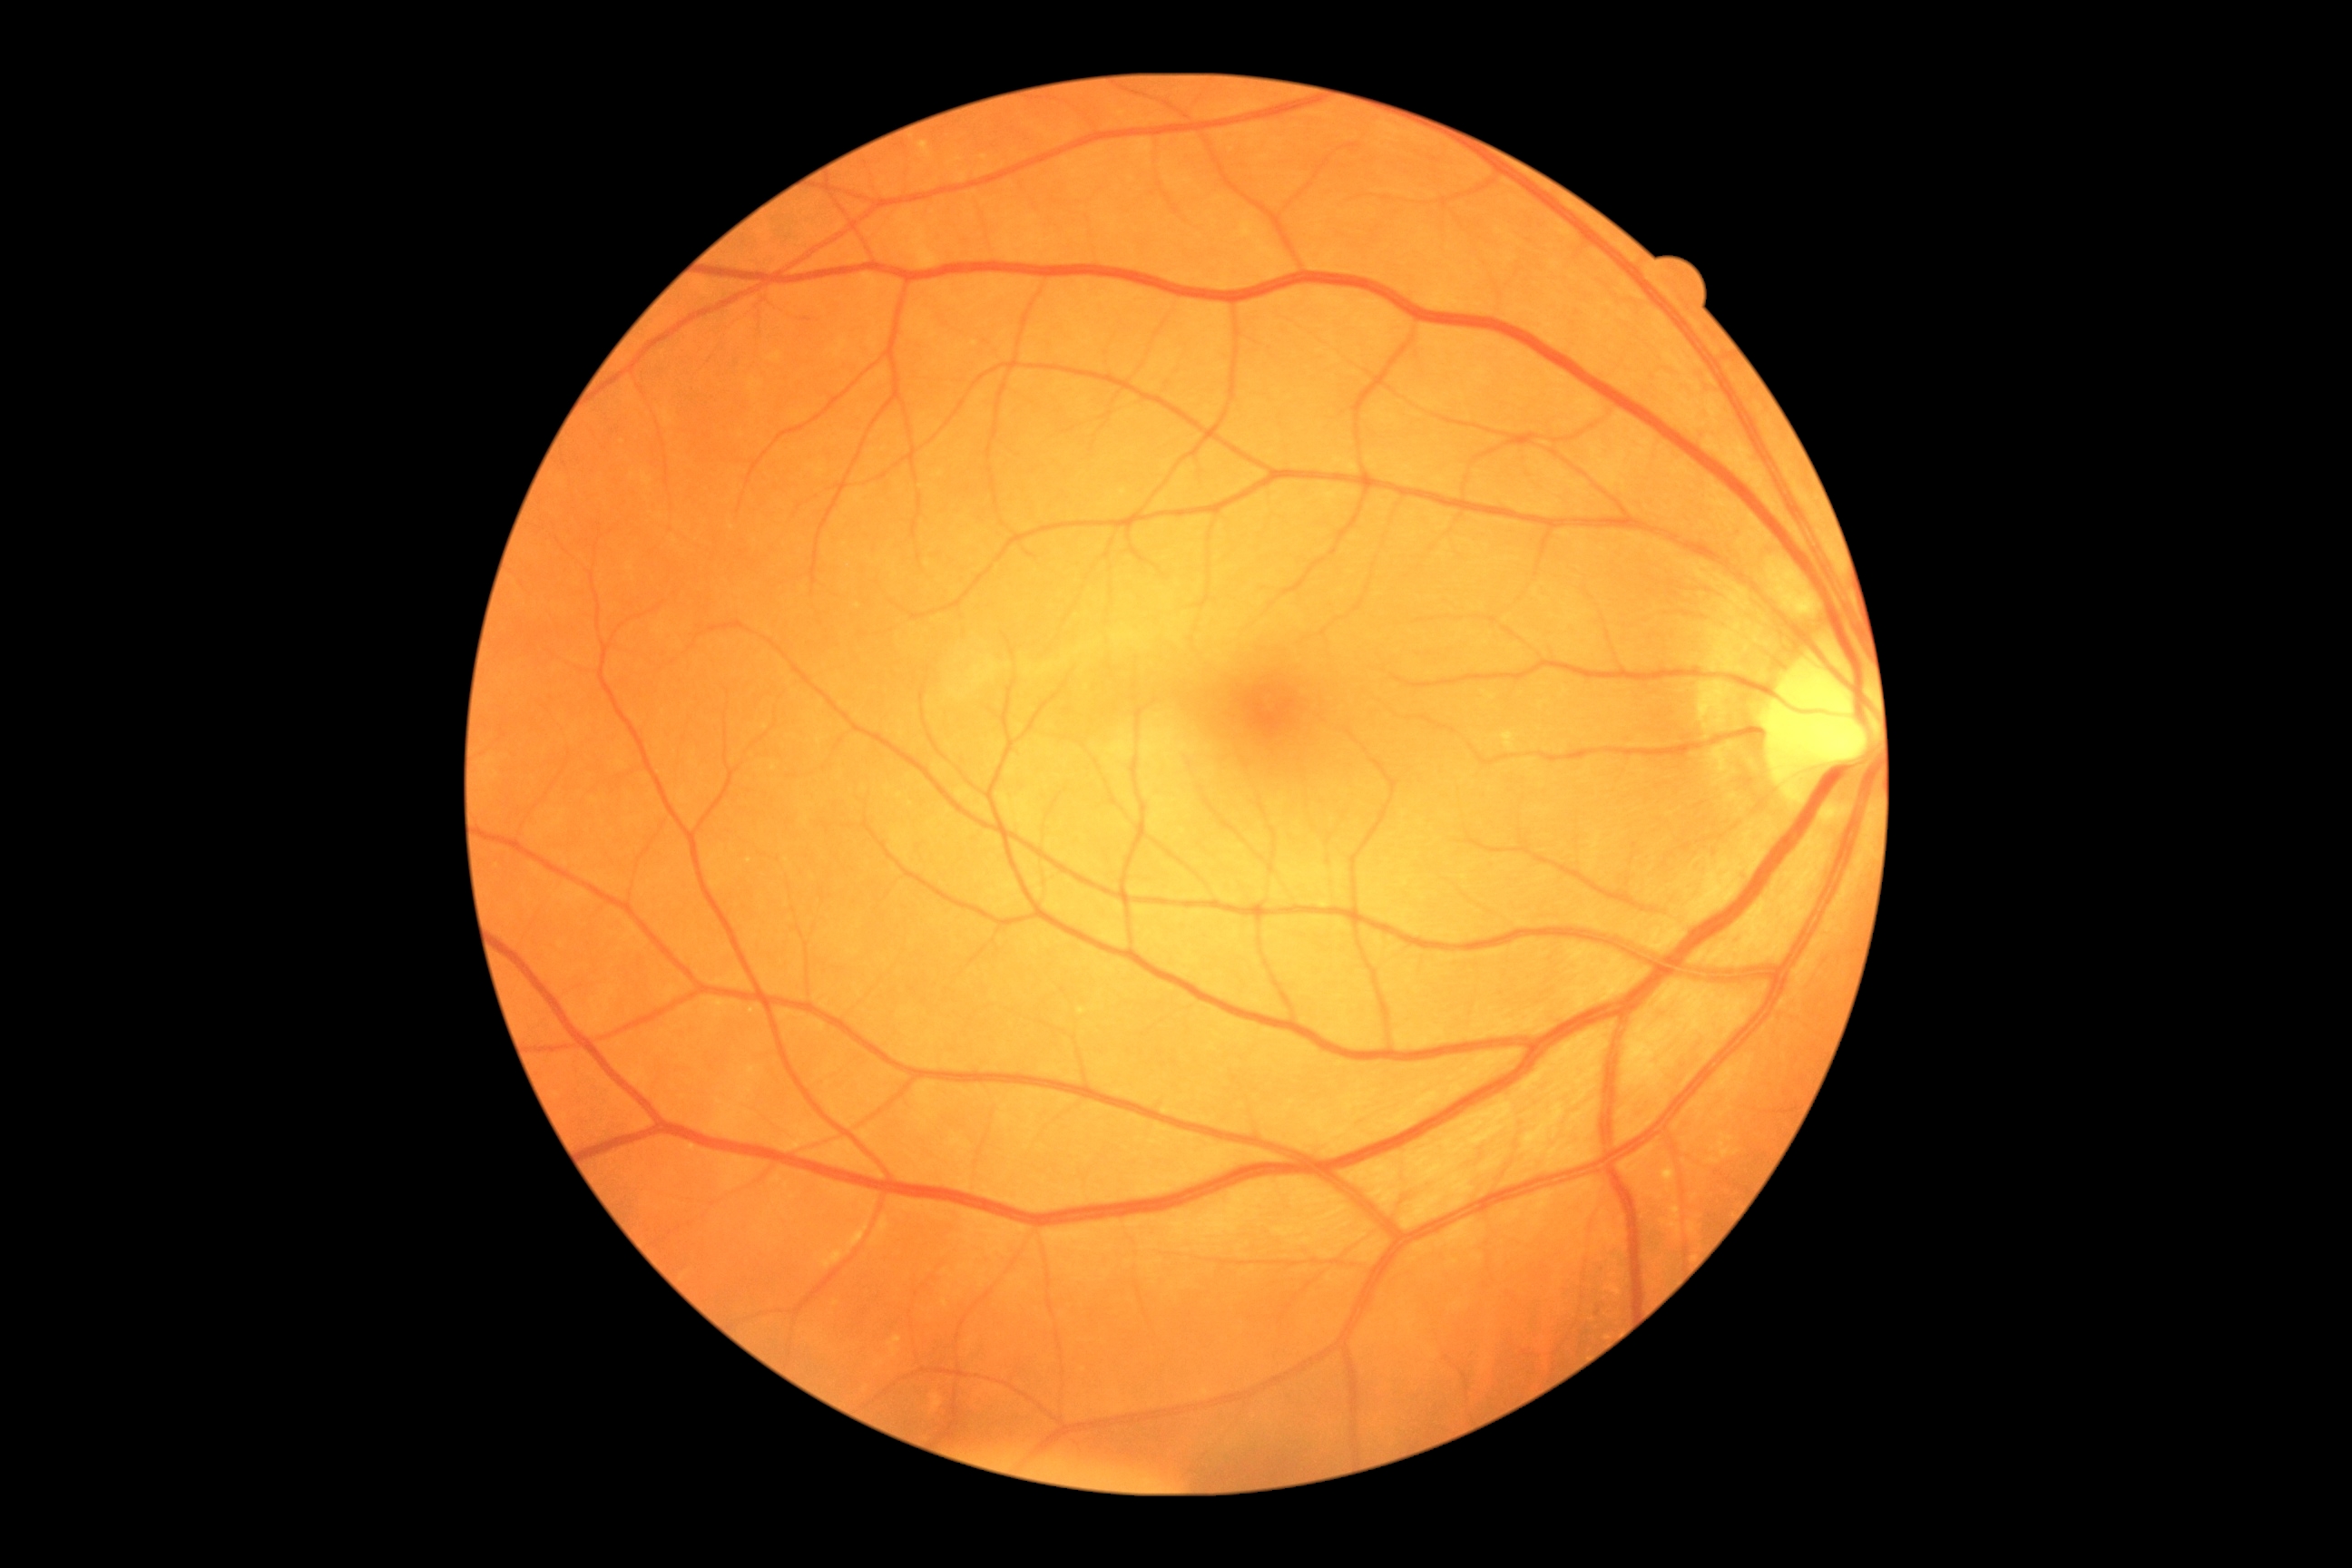 DR stage: grade 0 (no apparent retinopathy). No DR findings.